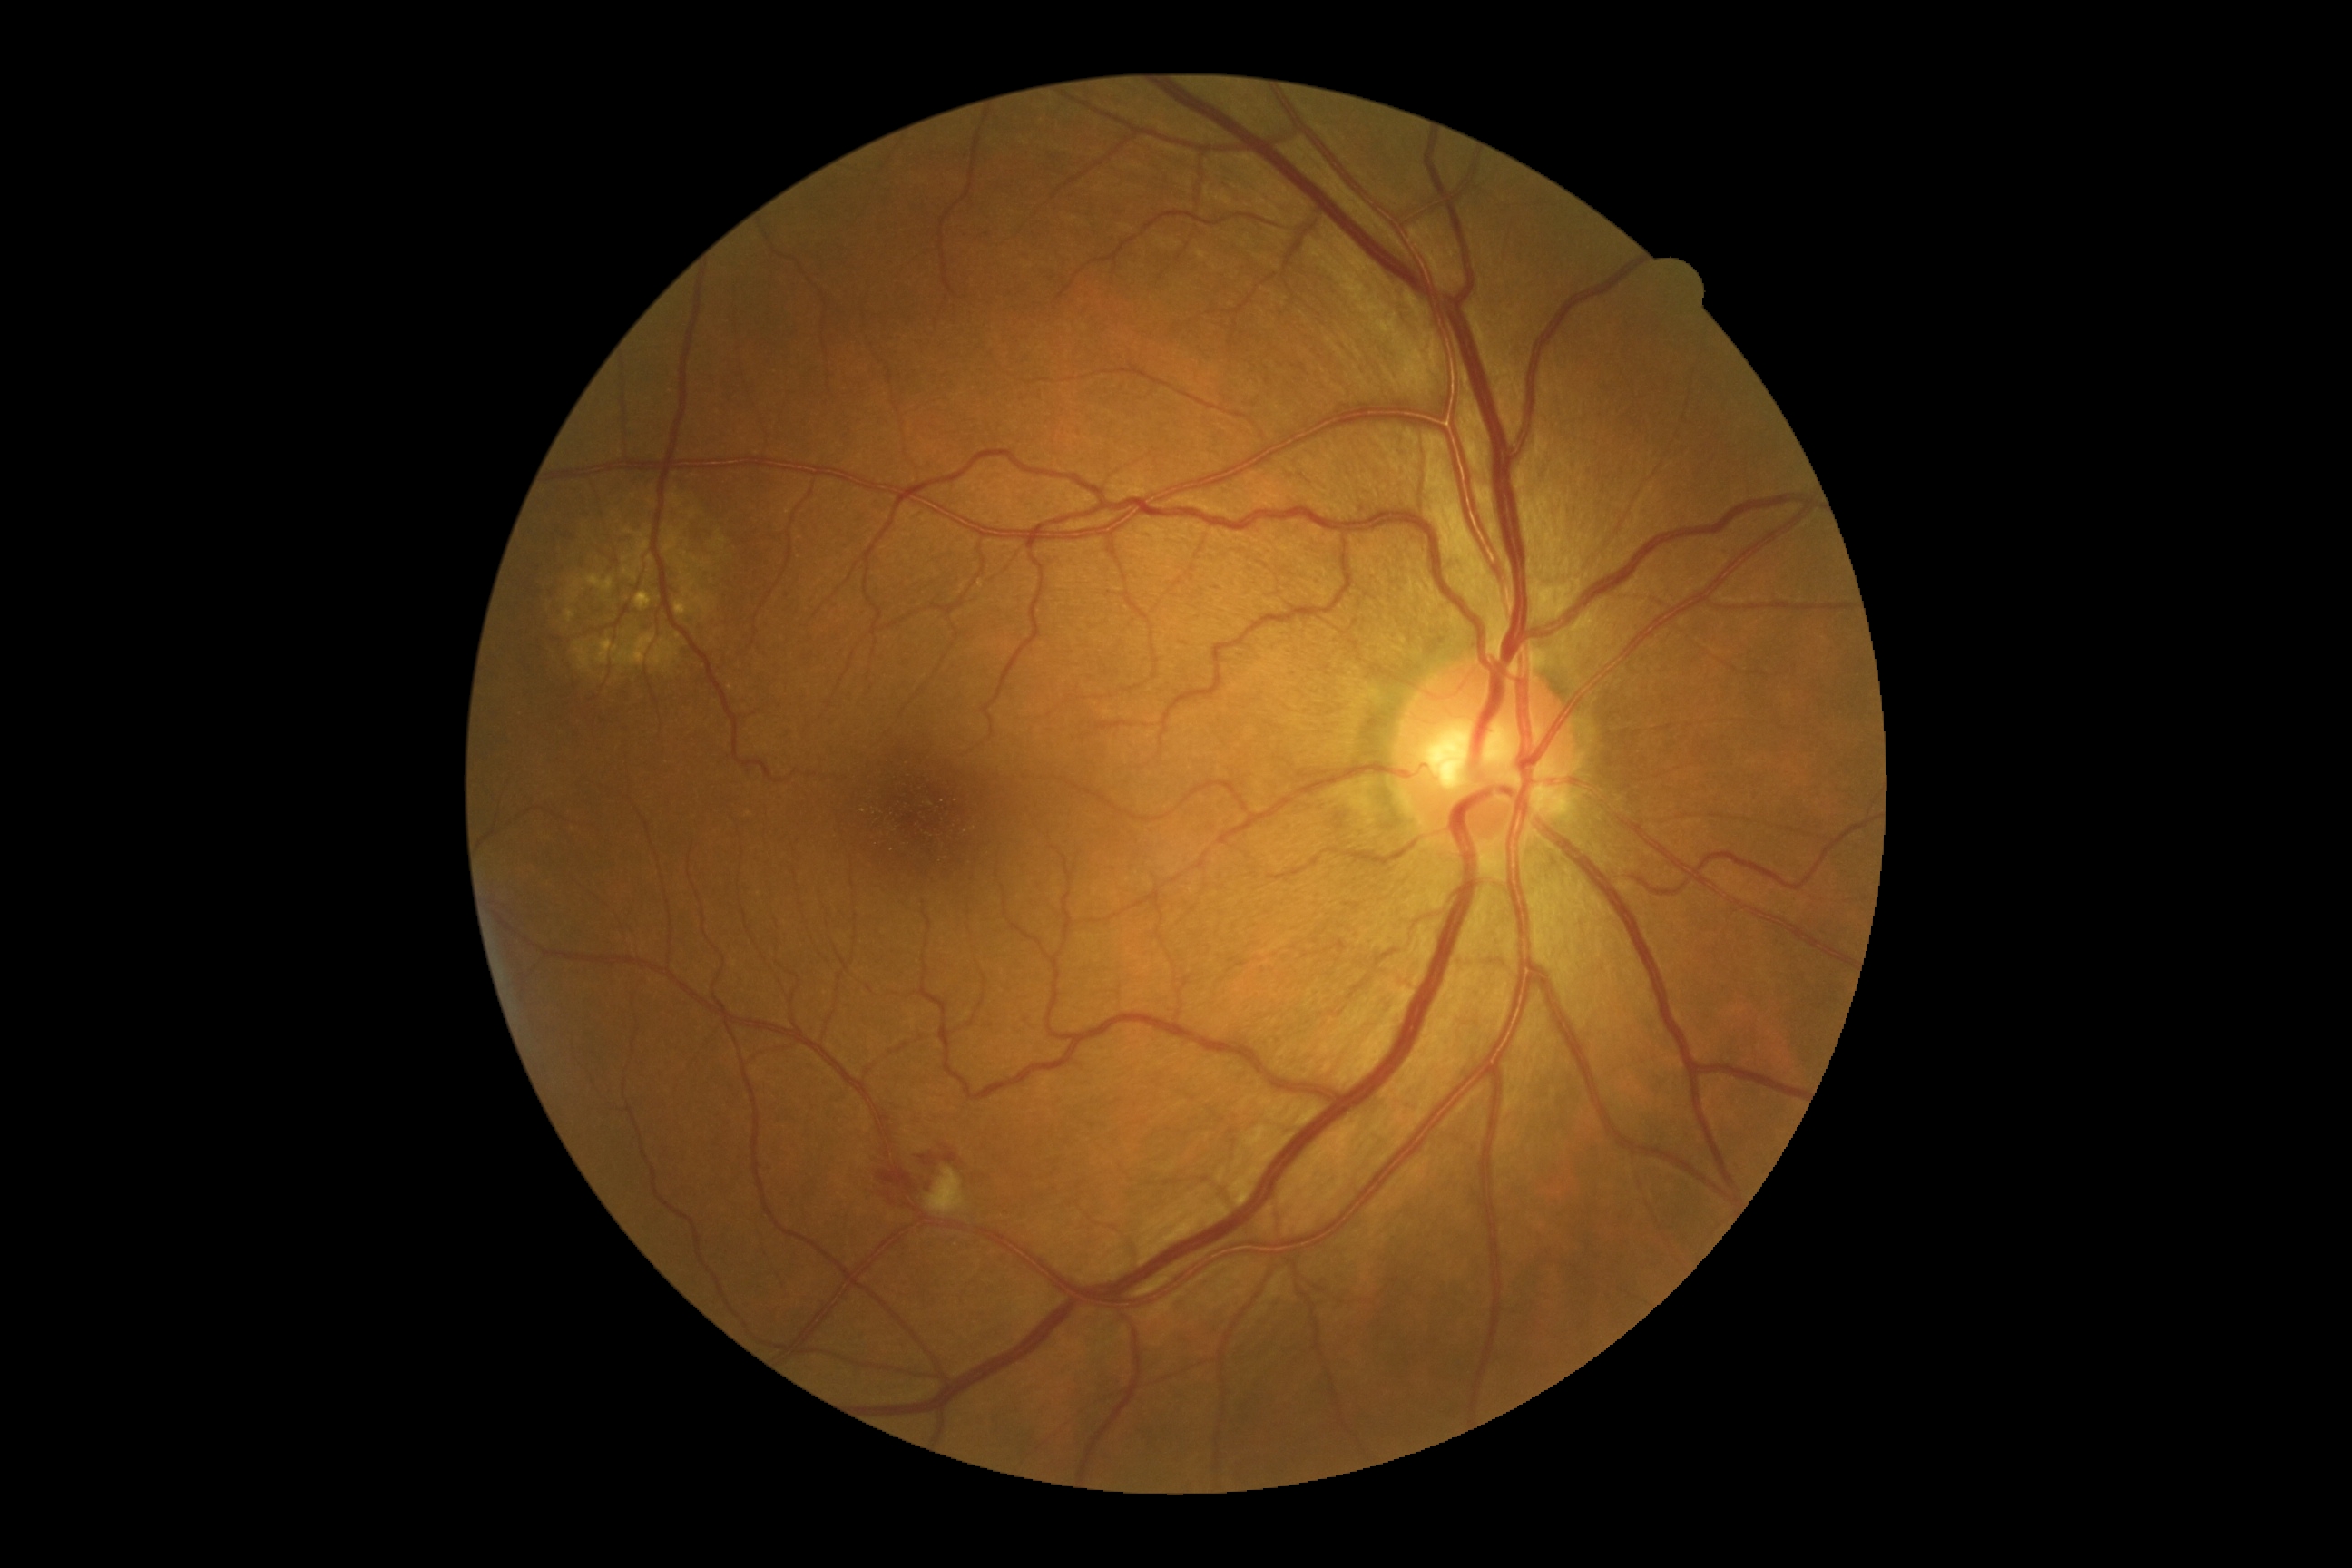
DR is 2.